Color fundus photograph. Acquired with a NIDEK AFC-230 — 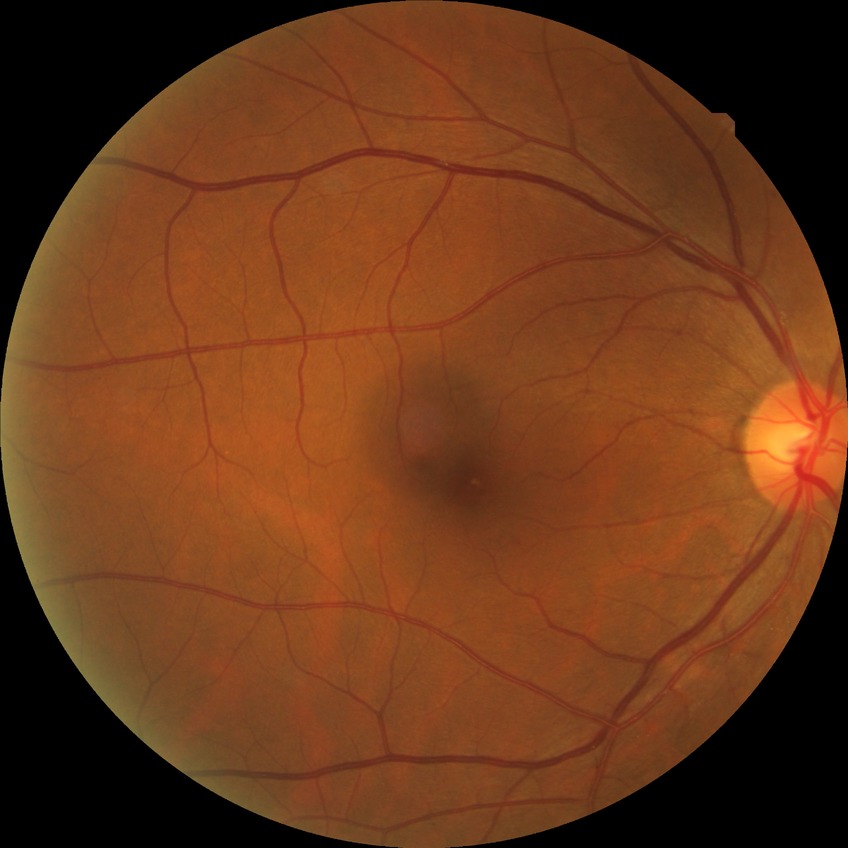
Diabetic retinopathy (DR): SDR (simple diabetic retinopathy).